45-degree field of view. Fundus photo. Diabetic retinopathy graded by the modified Davis classification — 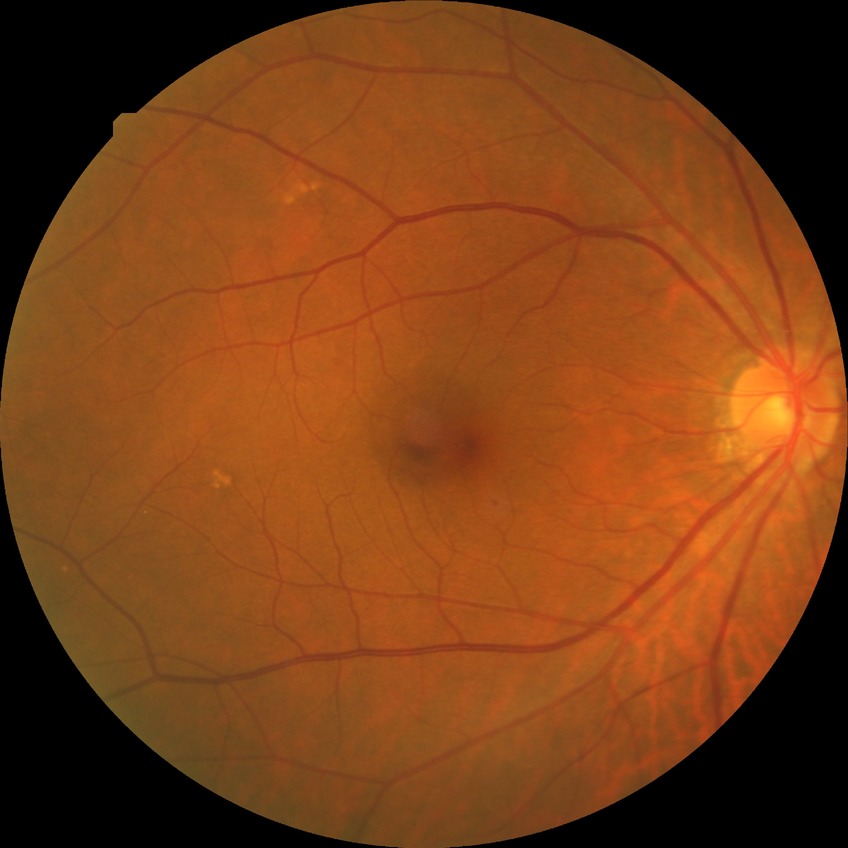
Modified Davis classification: simple diabetic retinopathy.